Wide-field contact fundus photograph of an infant. Captured with the Natus RetCam Envision (130° field of view) — 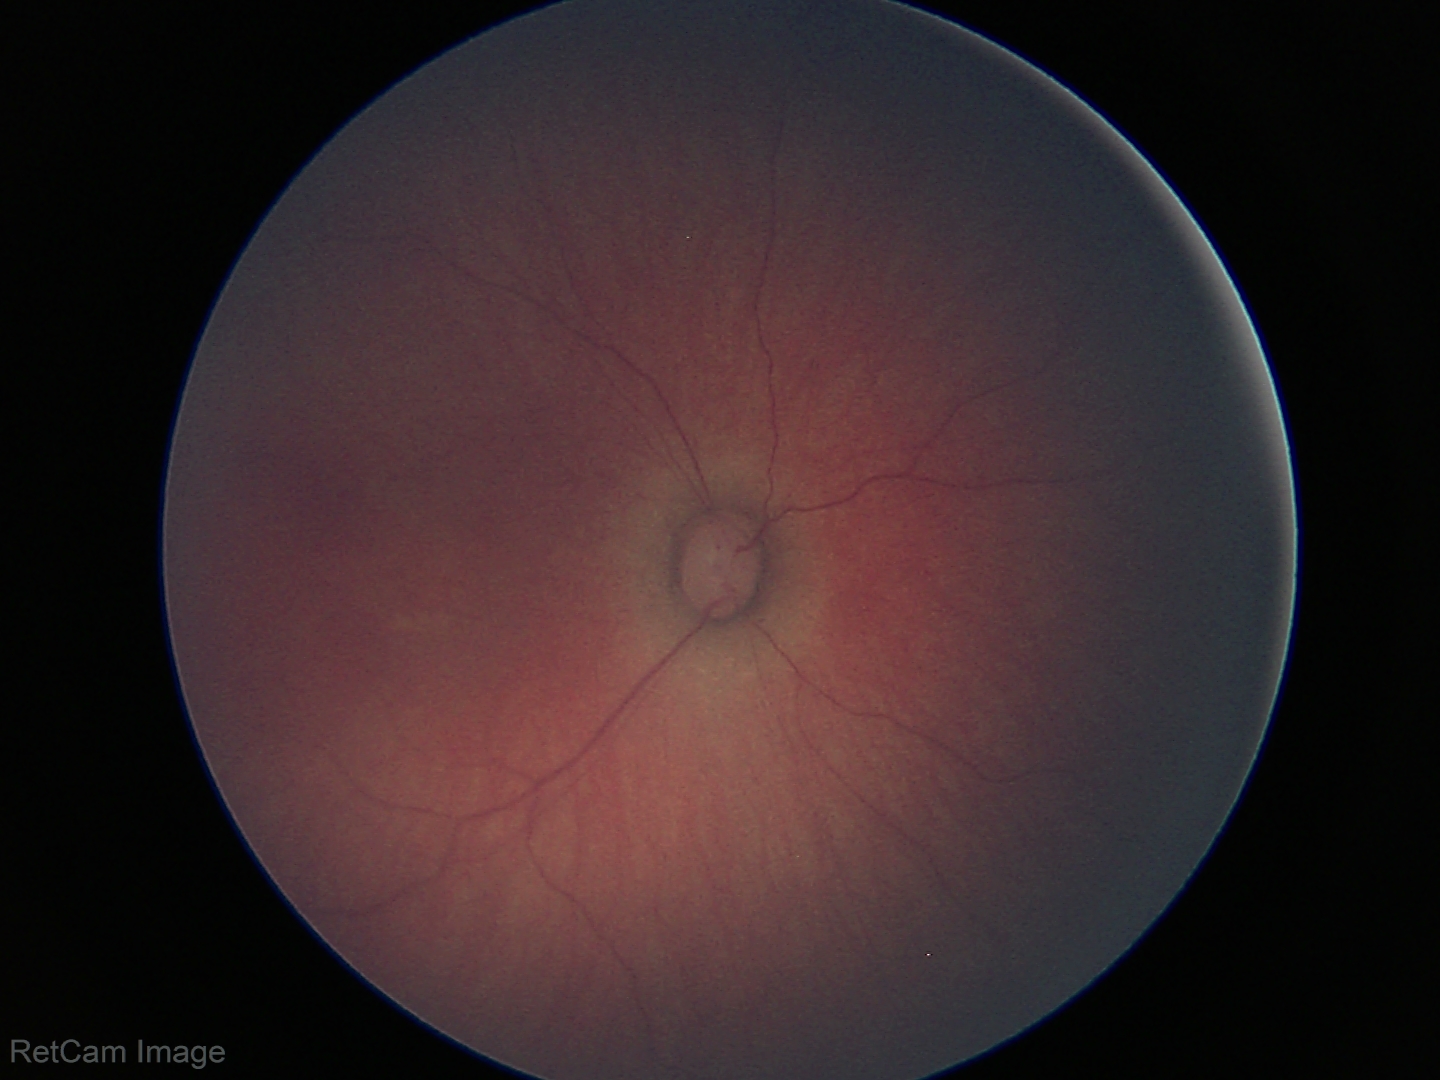
Impression: physiological finding.